Without pupil dilation, posterior pole color fundus photograph, NIDEK AFC-230 fundus camera
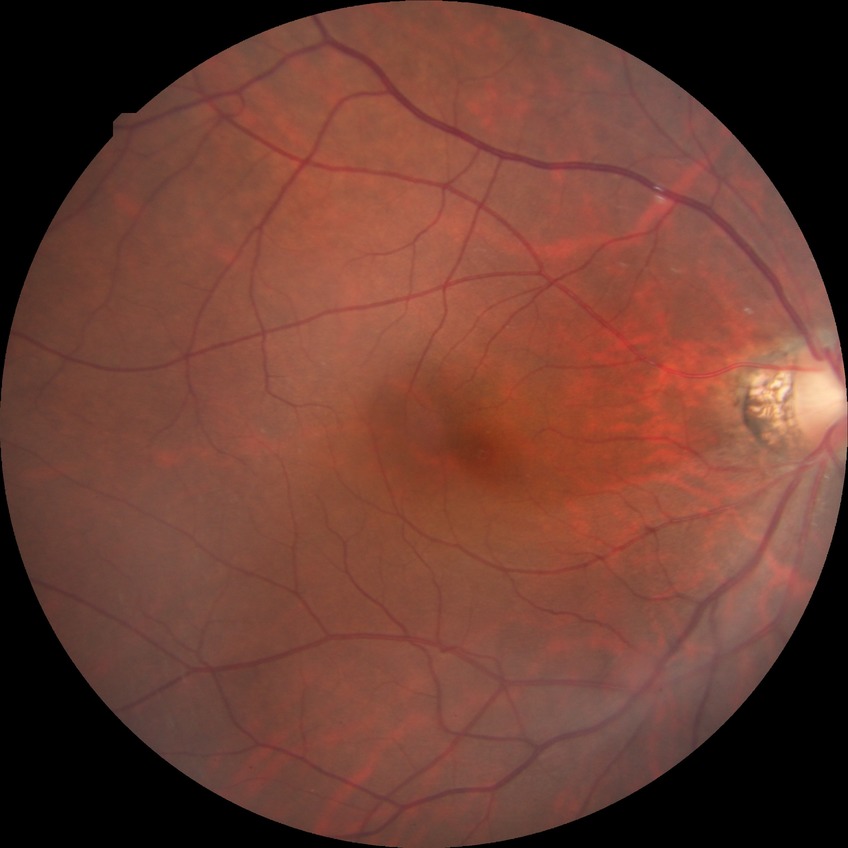
Findings:
* modified Davis grading: no diabetic retinopathy